Diabetic retinopathy graded by the modified Davis classification. CFP — 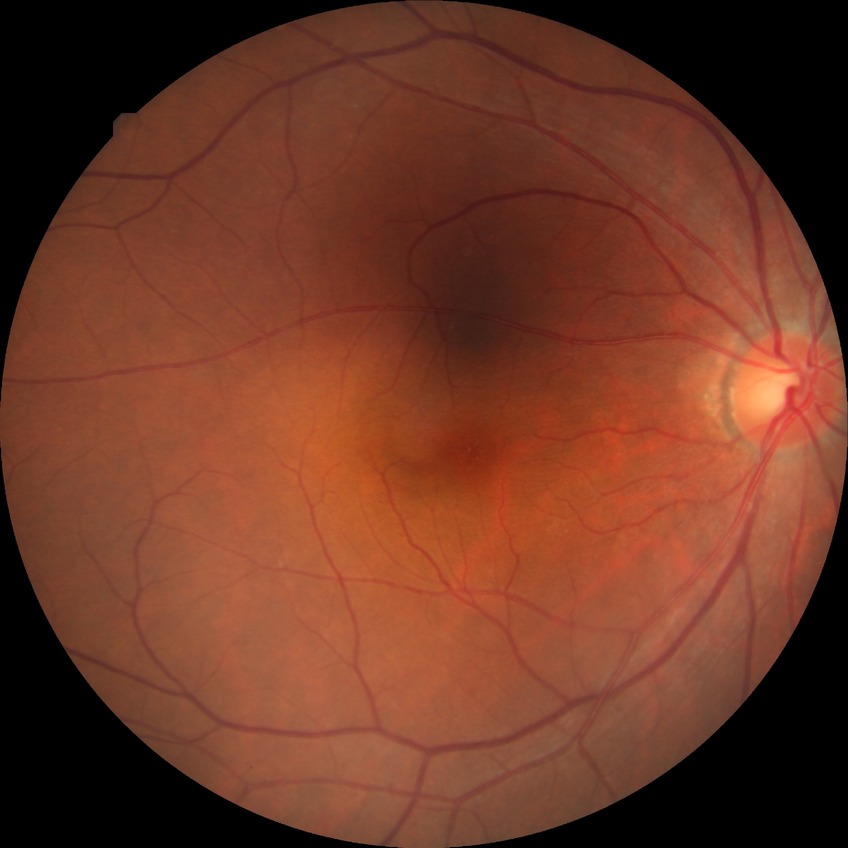

Diabetic retinopathy (DR) is no diabetic retinopathy (NDR).